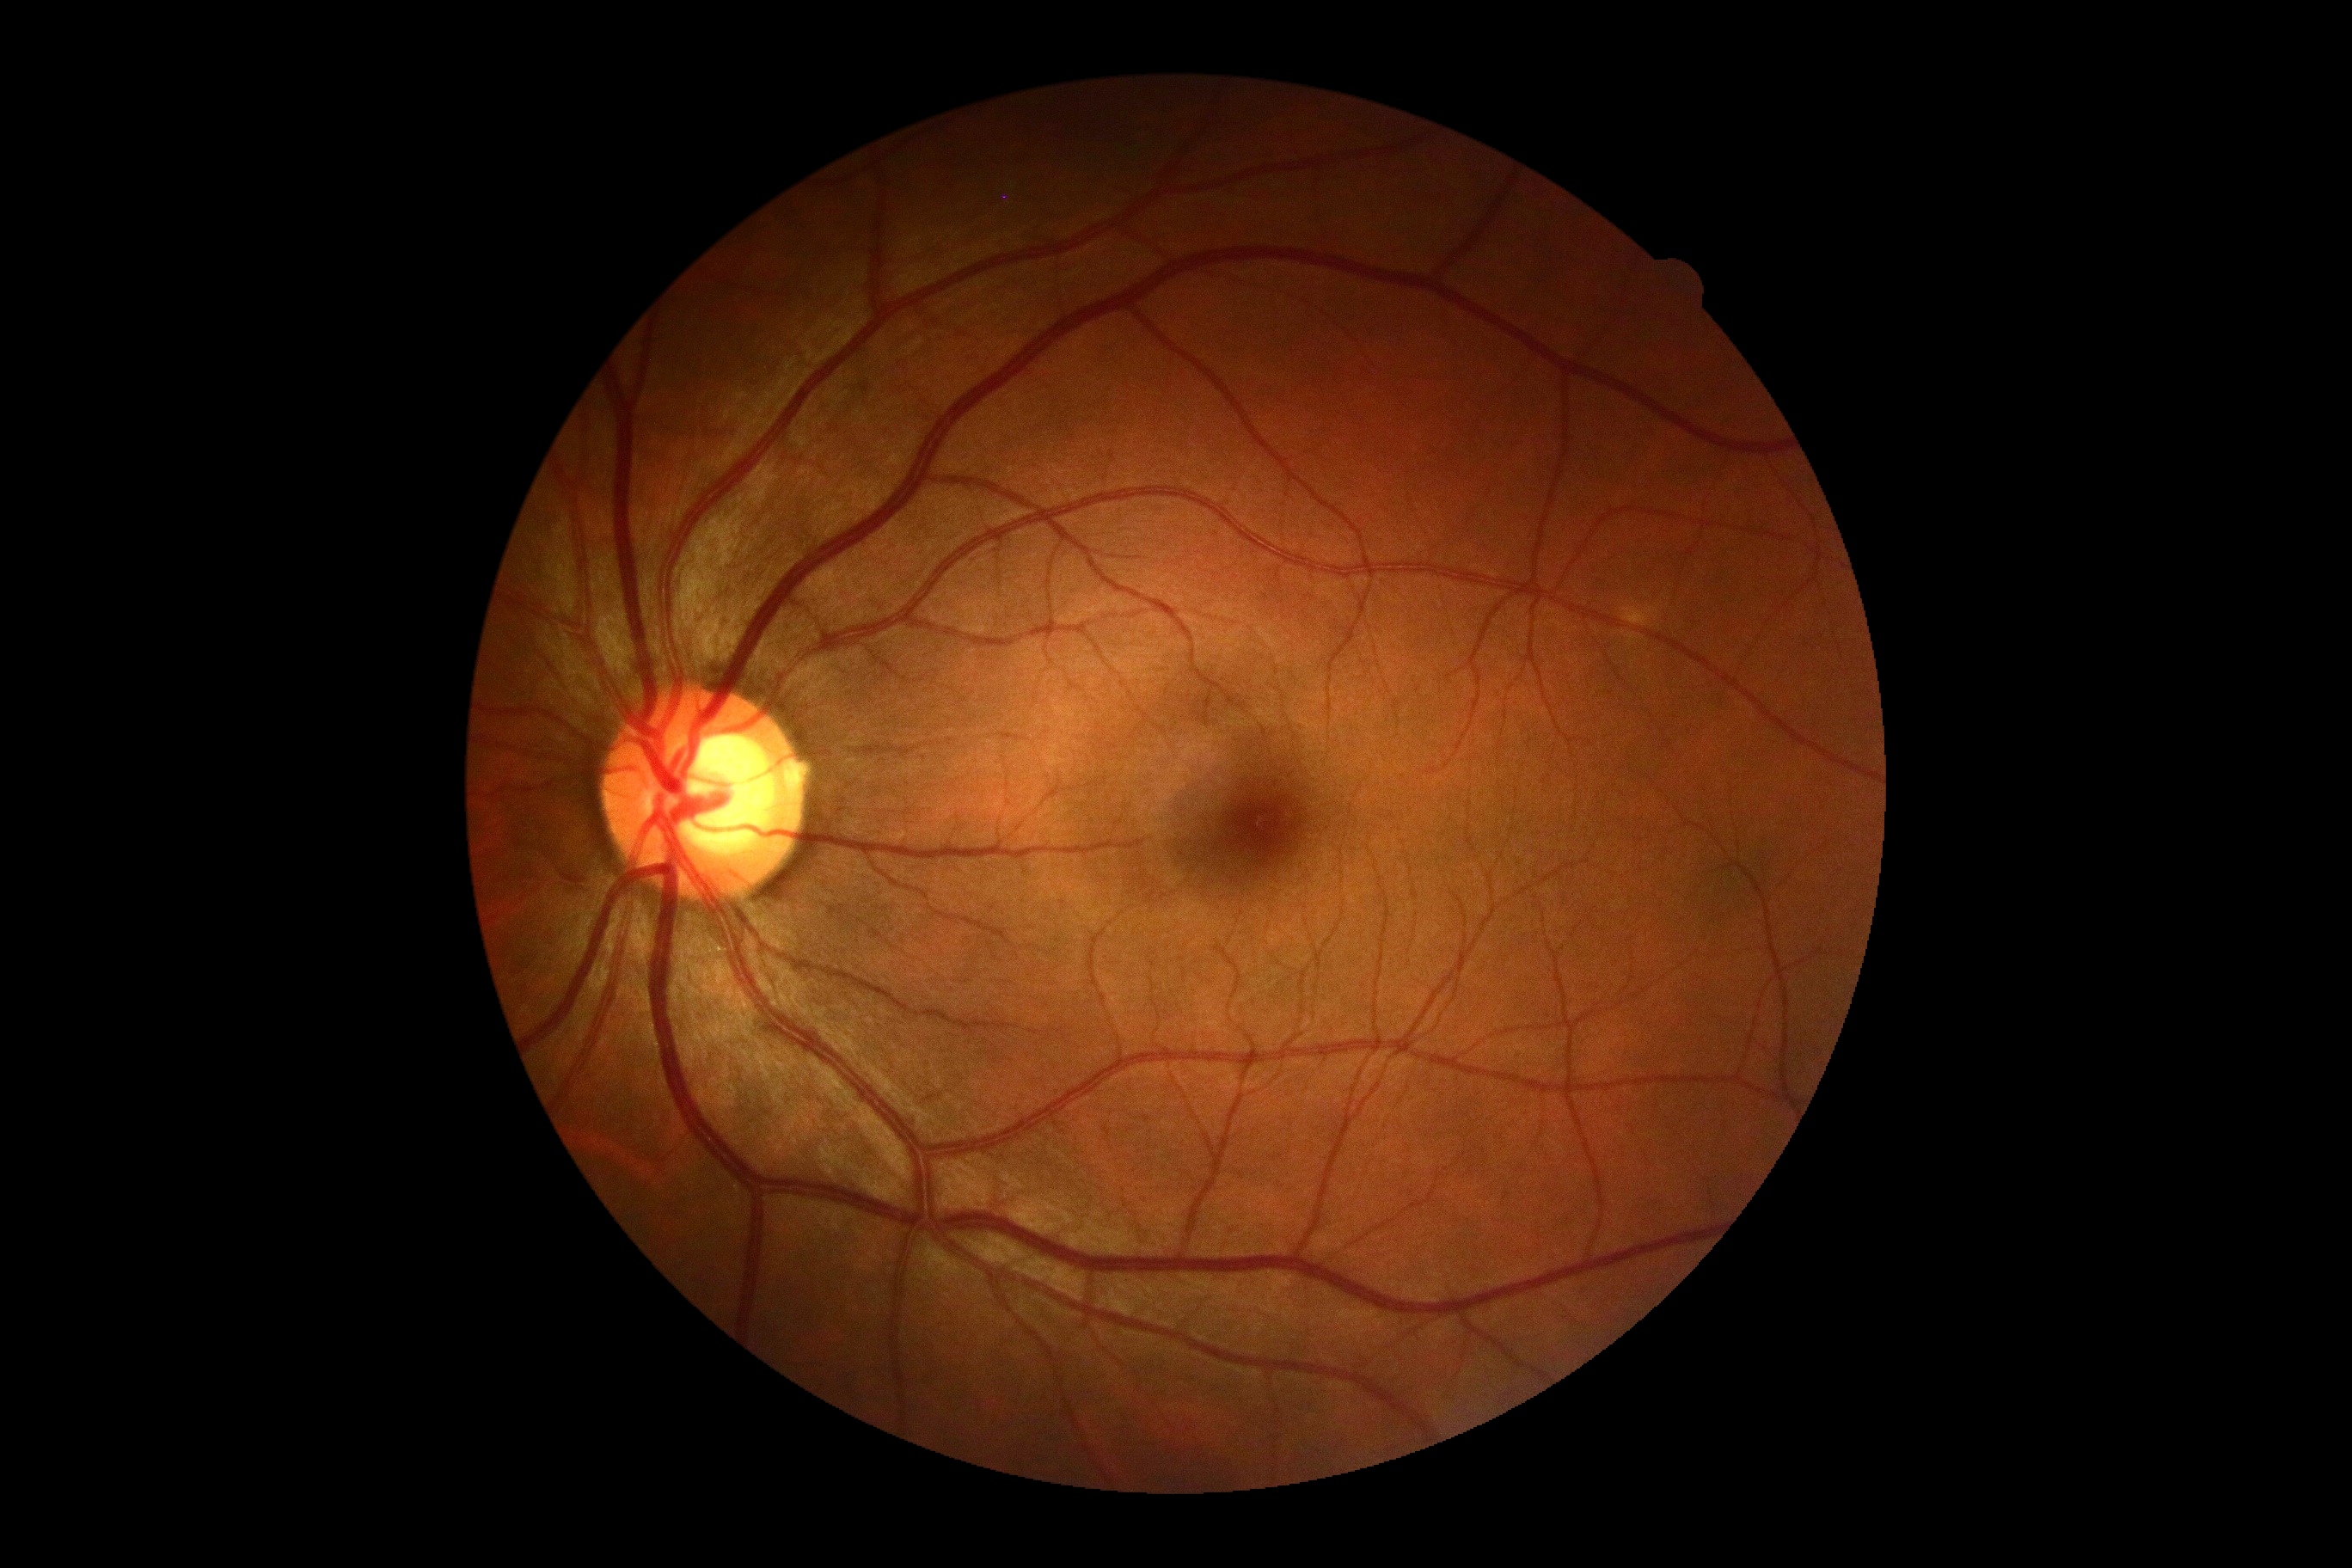

DR: no apparent retinopathy (grade 0). No diabetic retinal disease findings.